Color fundus photograph, 240x240px:
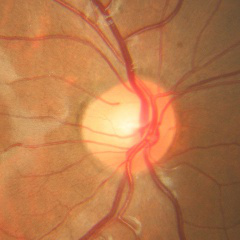 Optic disc appearance consistent with no signs of glaucoma.